Pediatric retinal photograph (wide-field). Image size 640x480. Acquired on the Clarity RetCam 3:
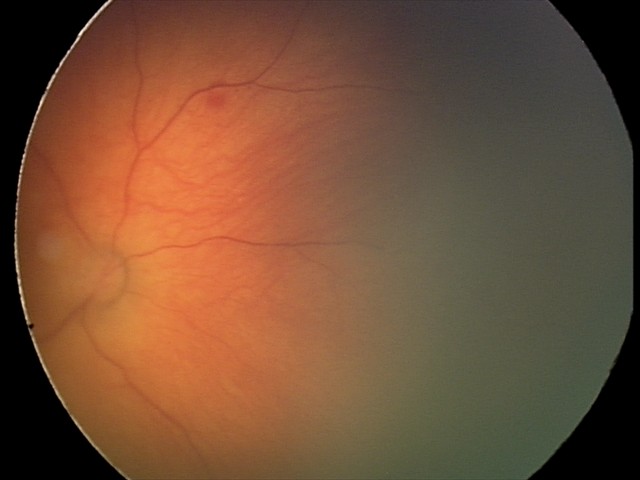

Screening examination consistent with toxoplasmosis chorioretinitis.